Diabetic retinopathy graded by the modified Davis classification:
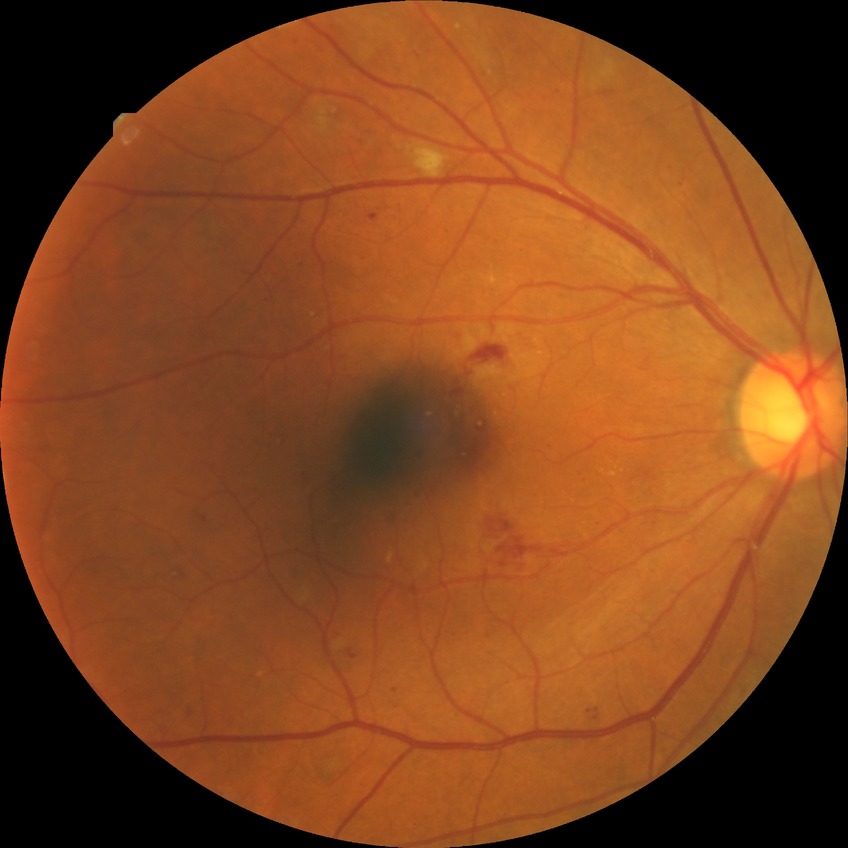
DR class: non-proliferative diabetic retinopathy. Diabetic retinopathy grade: pre-proliferative diabetic retinopathy.